Diabetic retinopathy graded by the modified Davis classification:
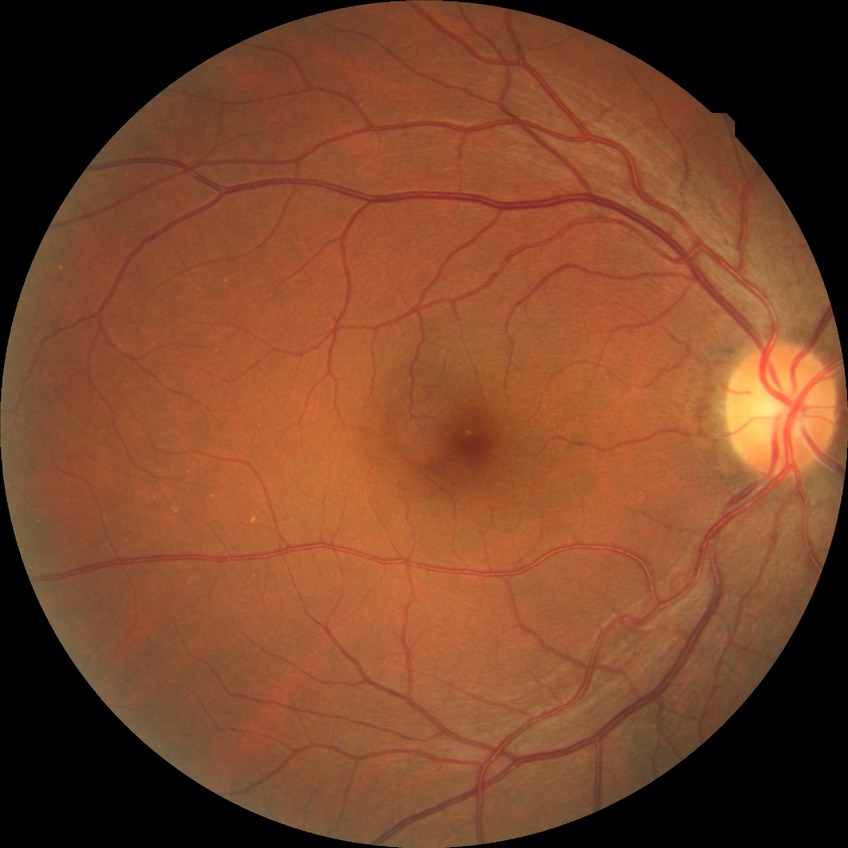

Diabetic retinopathy (DR) is NDR (no diabetic retinopathy).